Without pupil dilation; modified Davis grading: 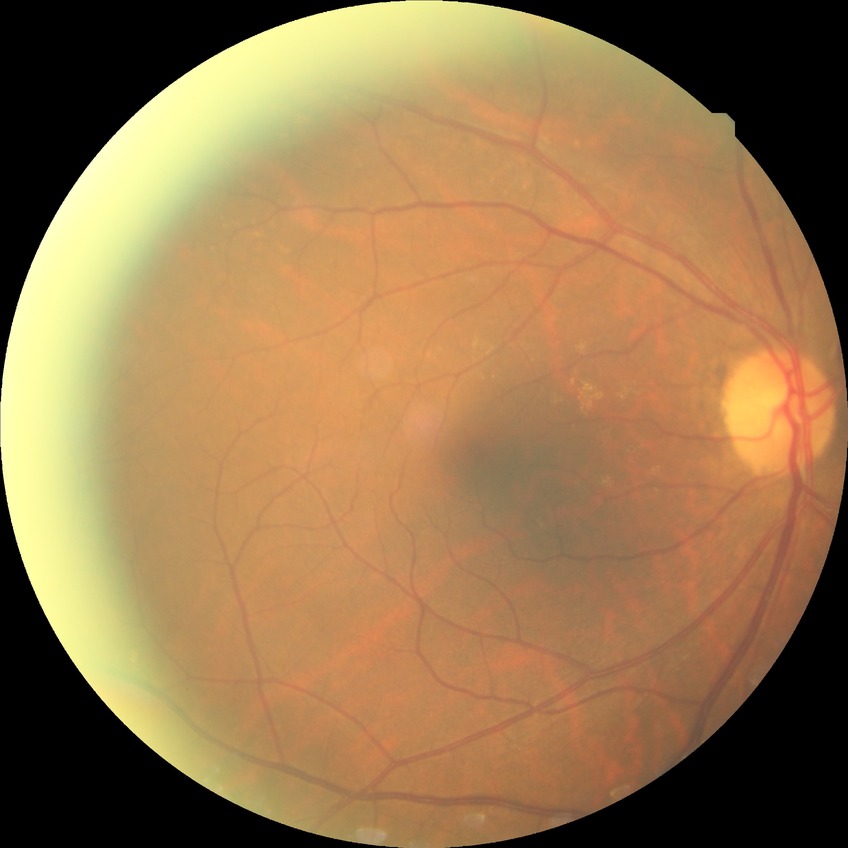   davis_grade: NDR (no diabetic retinopathy)